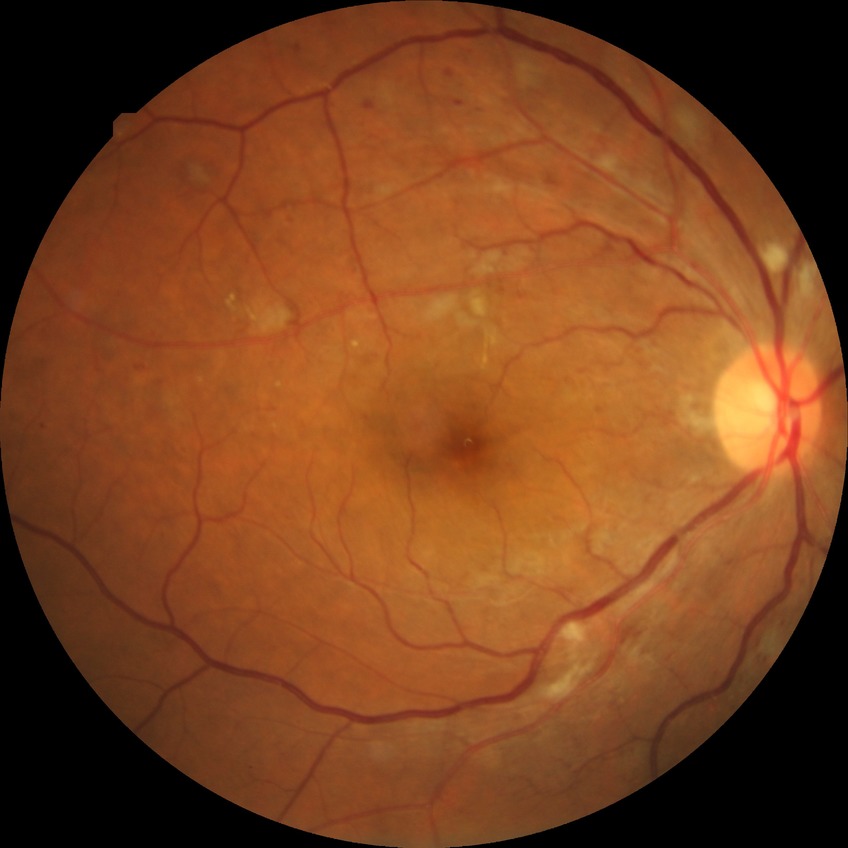

Diabetic retinopathy (DR): PPDR (pre-proliferative diabetic retinopathy).